2184 x 1690 pixels:
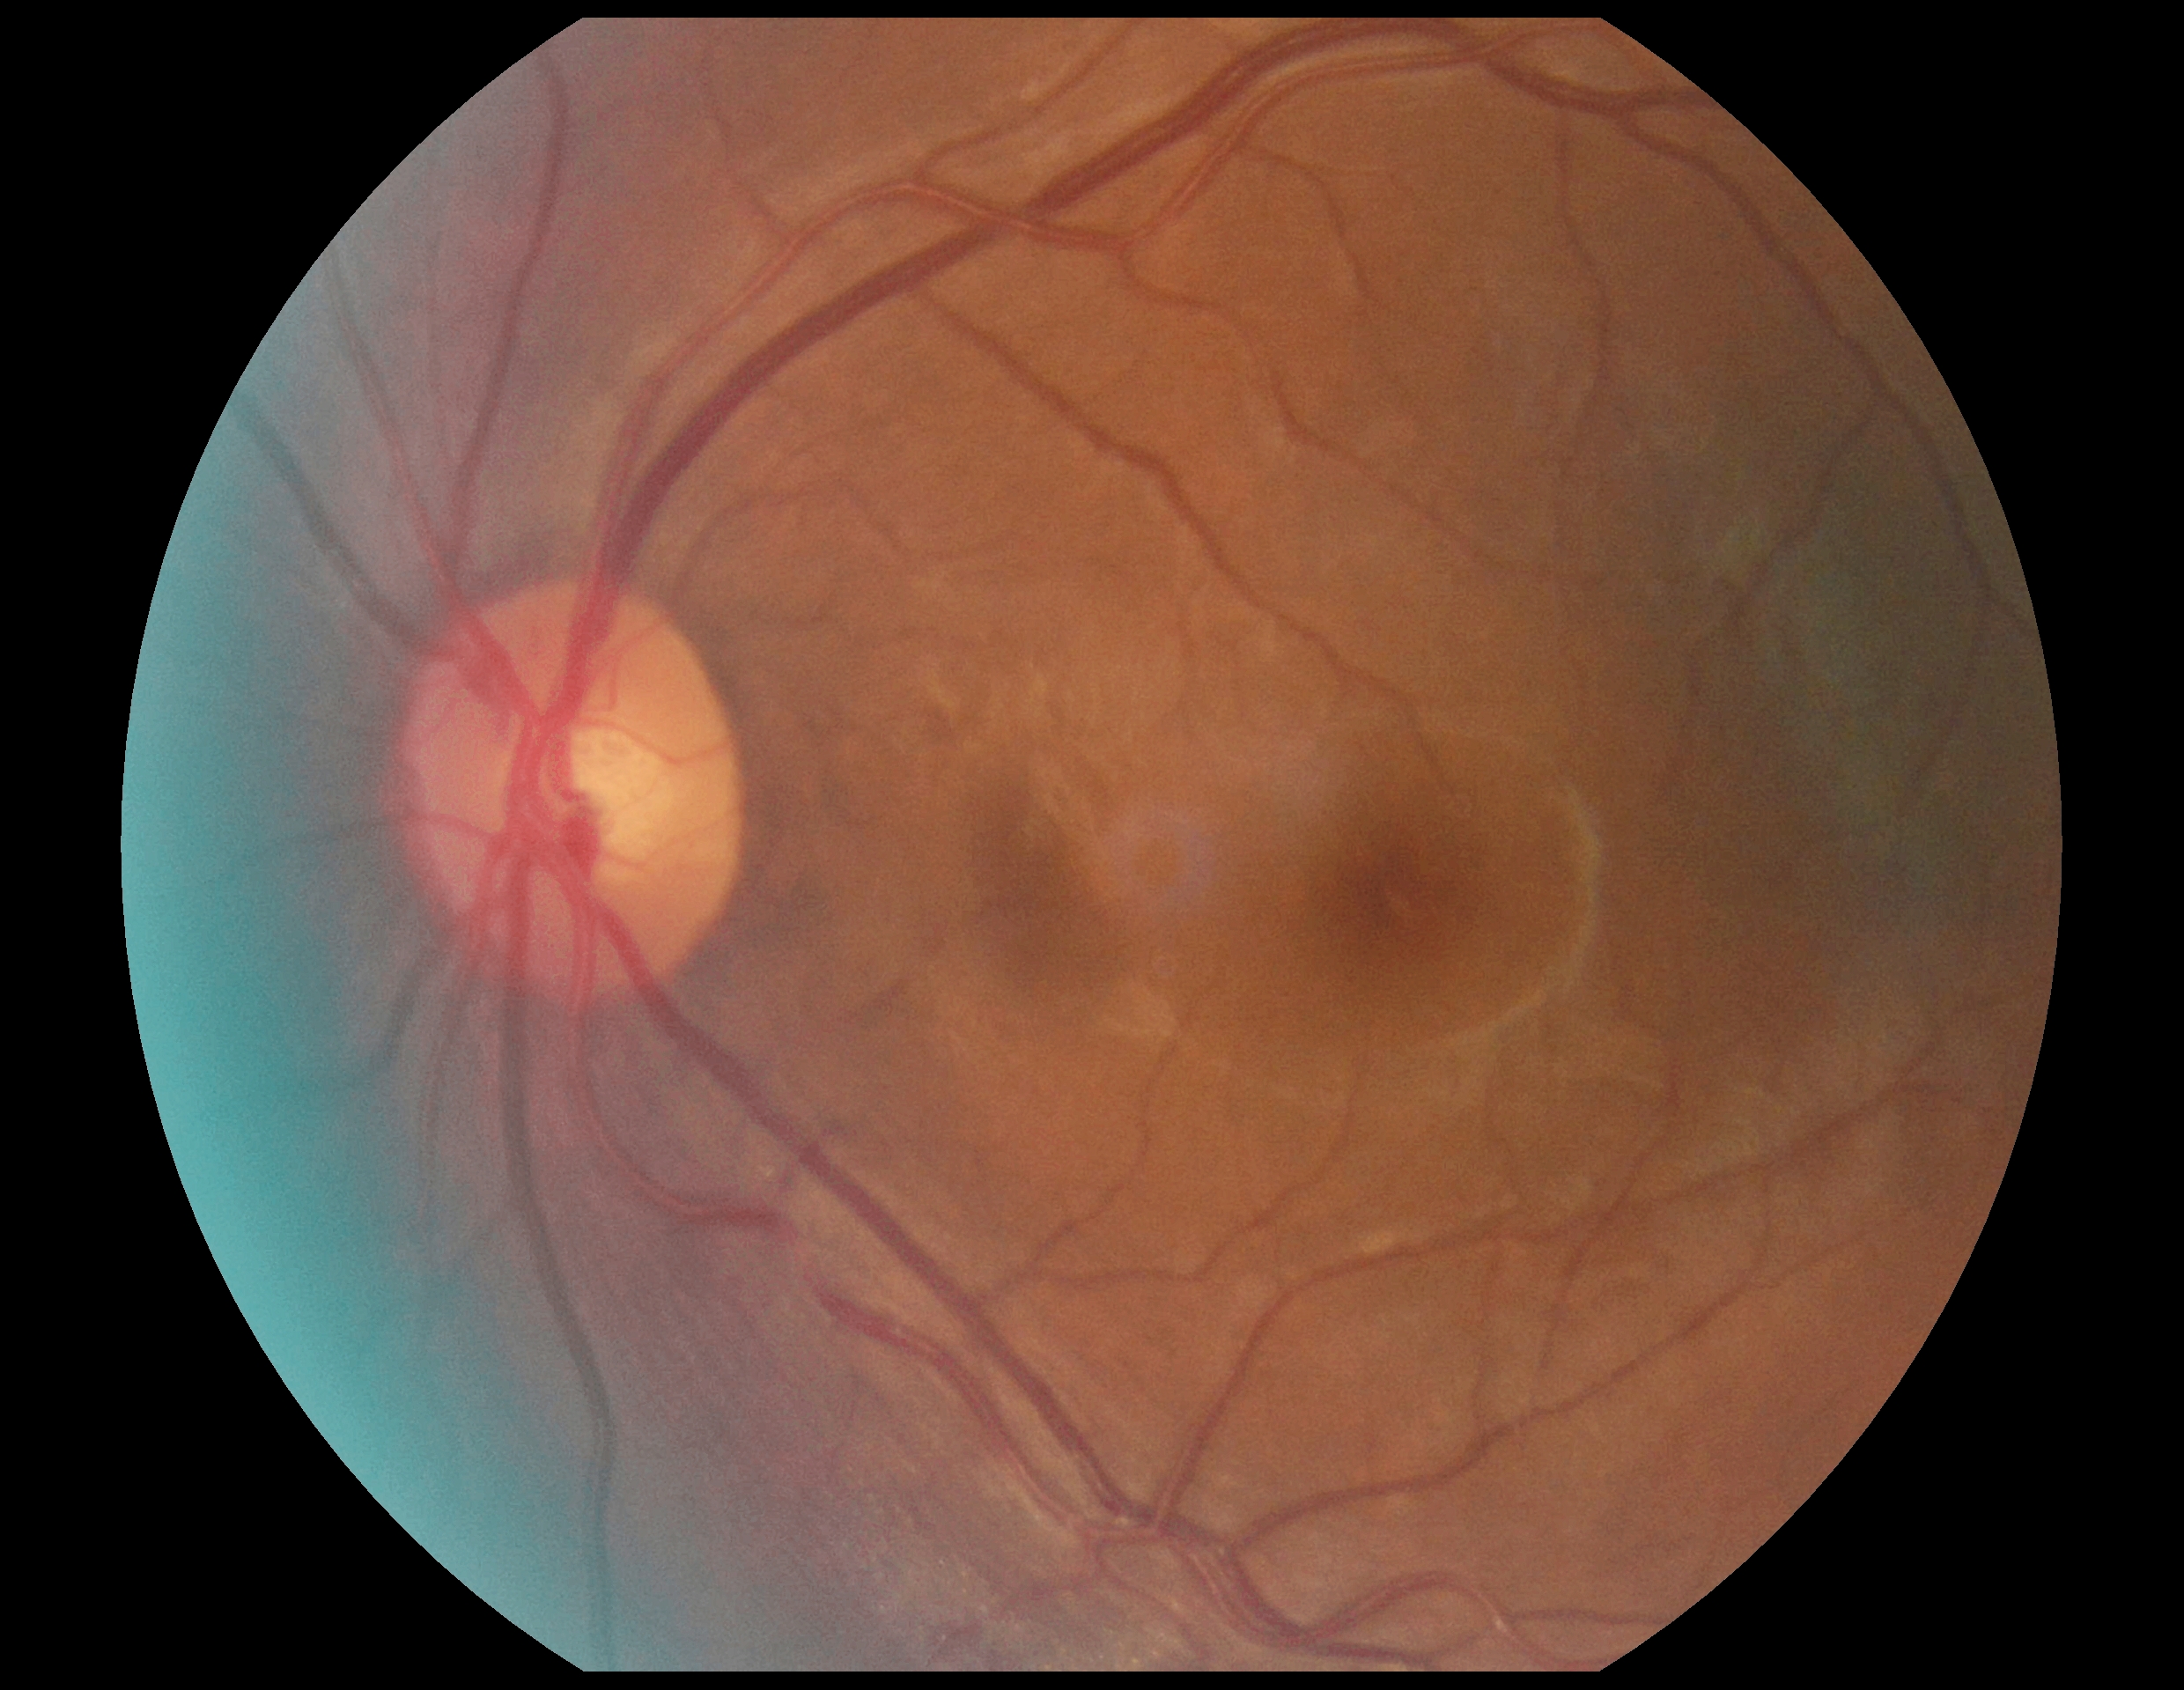

Retinopathy grade: no apparent diabetic retinopathy (0) — no visible signs of diabetic retinopathy. No diabetic retinal disease findings.